130° field of view (Clarity RetCam 3). Infant wide-field fundus photograph.
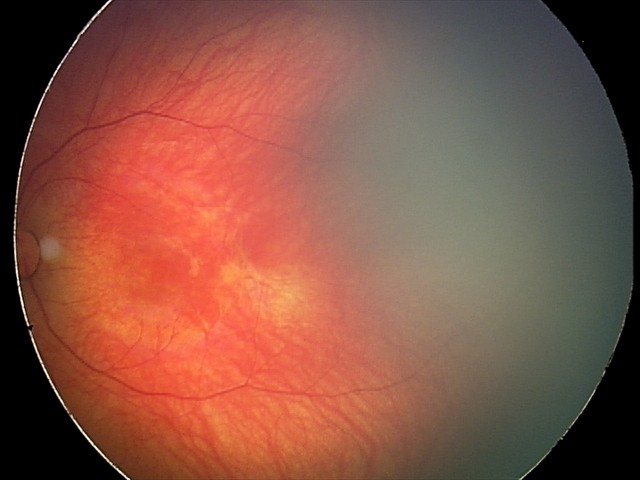

From an examination with diagnosis of retinal hemorrhages.